NIDEK AFC-230; 45 degree fundus photograph: 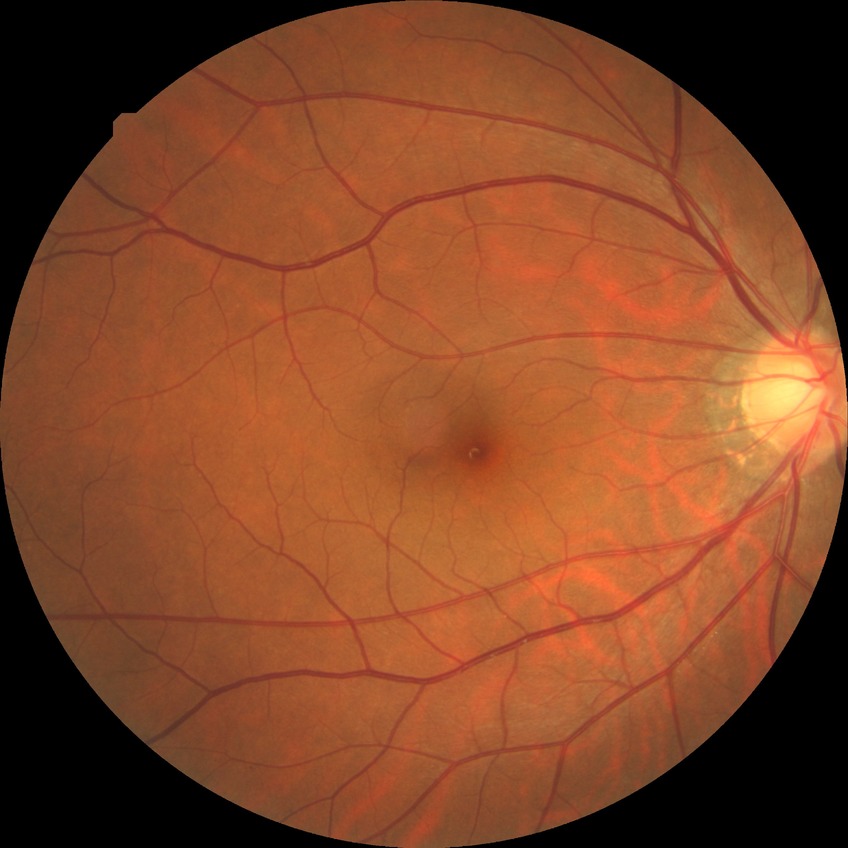
Annotations:
- diabetic retinopathy stage: no diabetic retinopathy